2048x1536px: 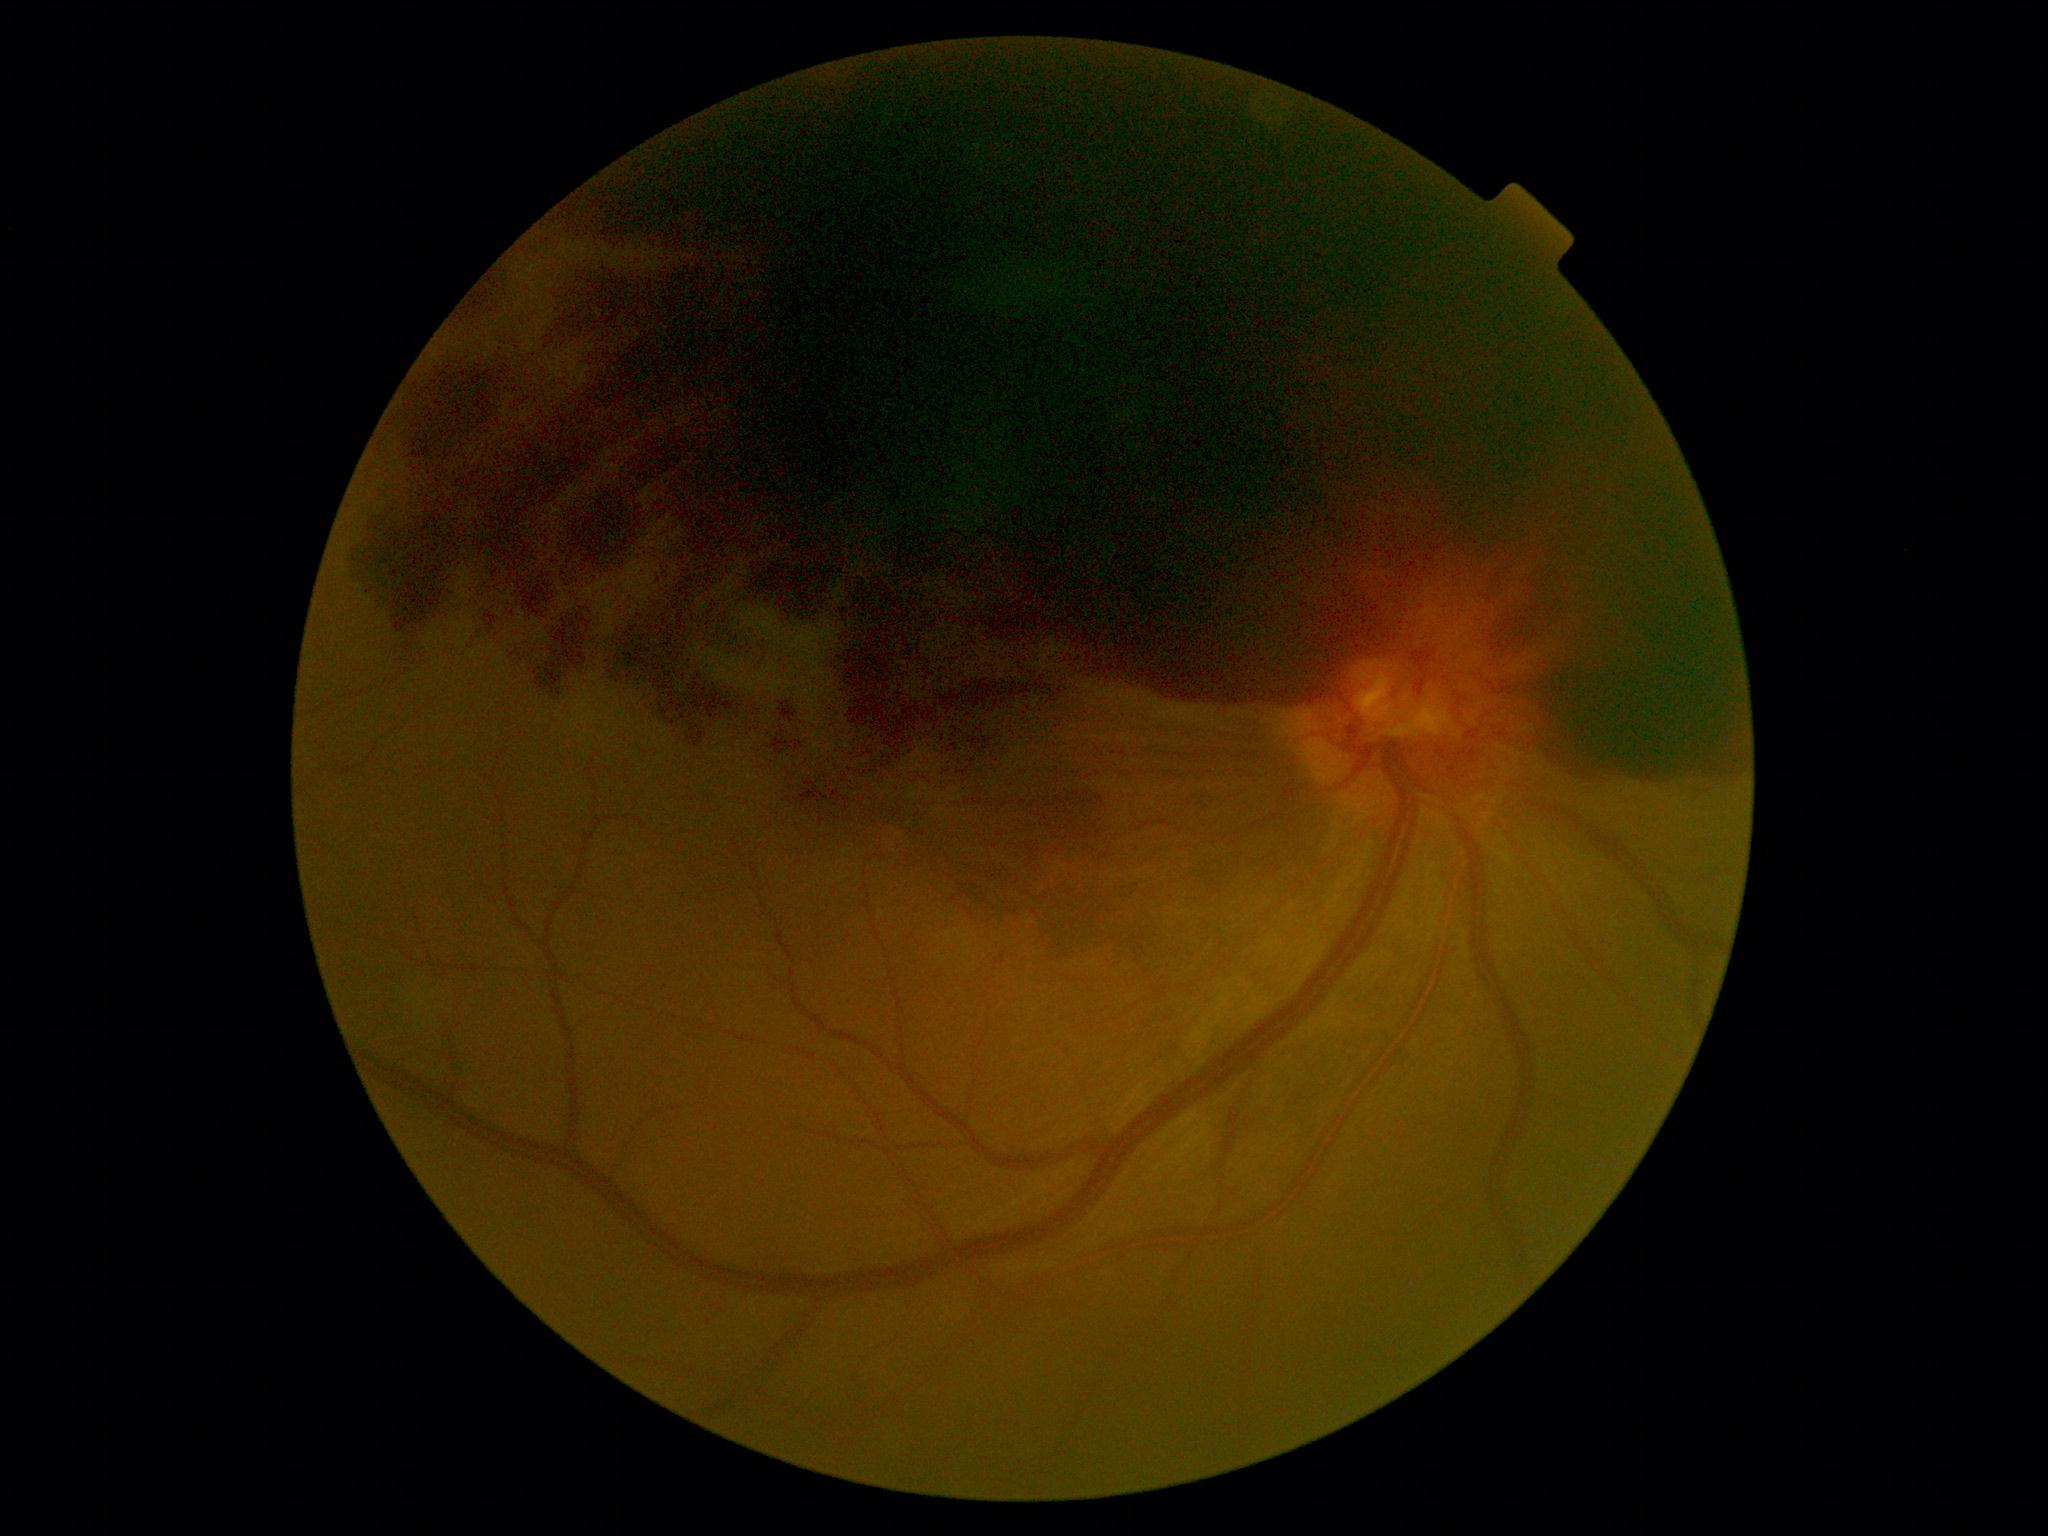

  dr_grade: 4 — neovascularization and/or vitreous/pre-retinal hemorrhage